FOV: 45 degrees; CFP; 2352 x 1568 pixels:
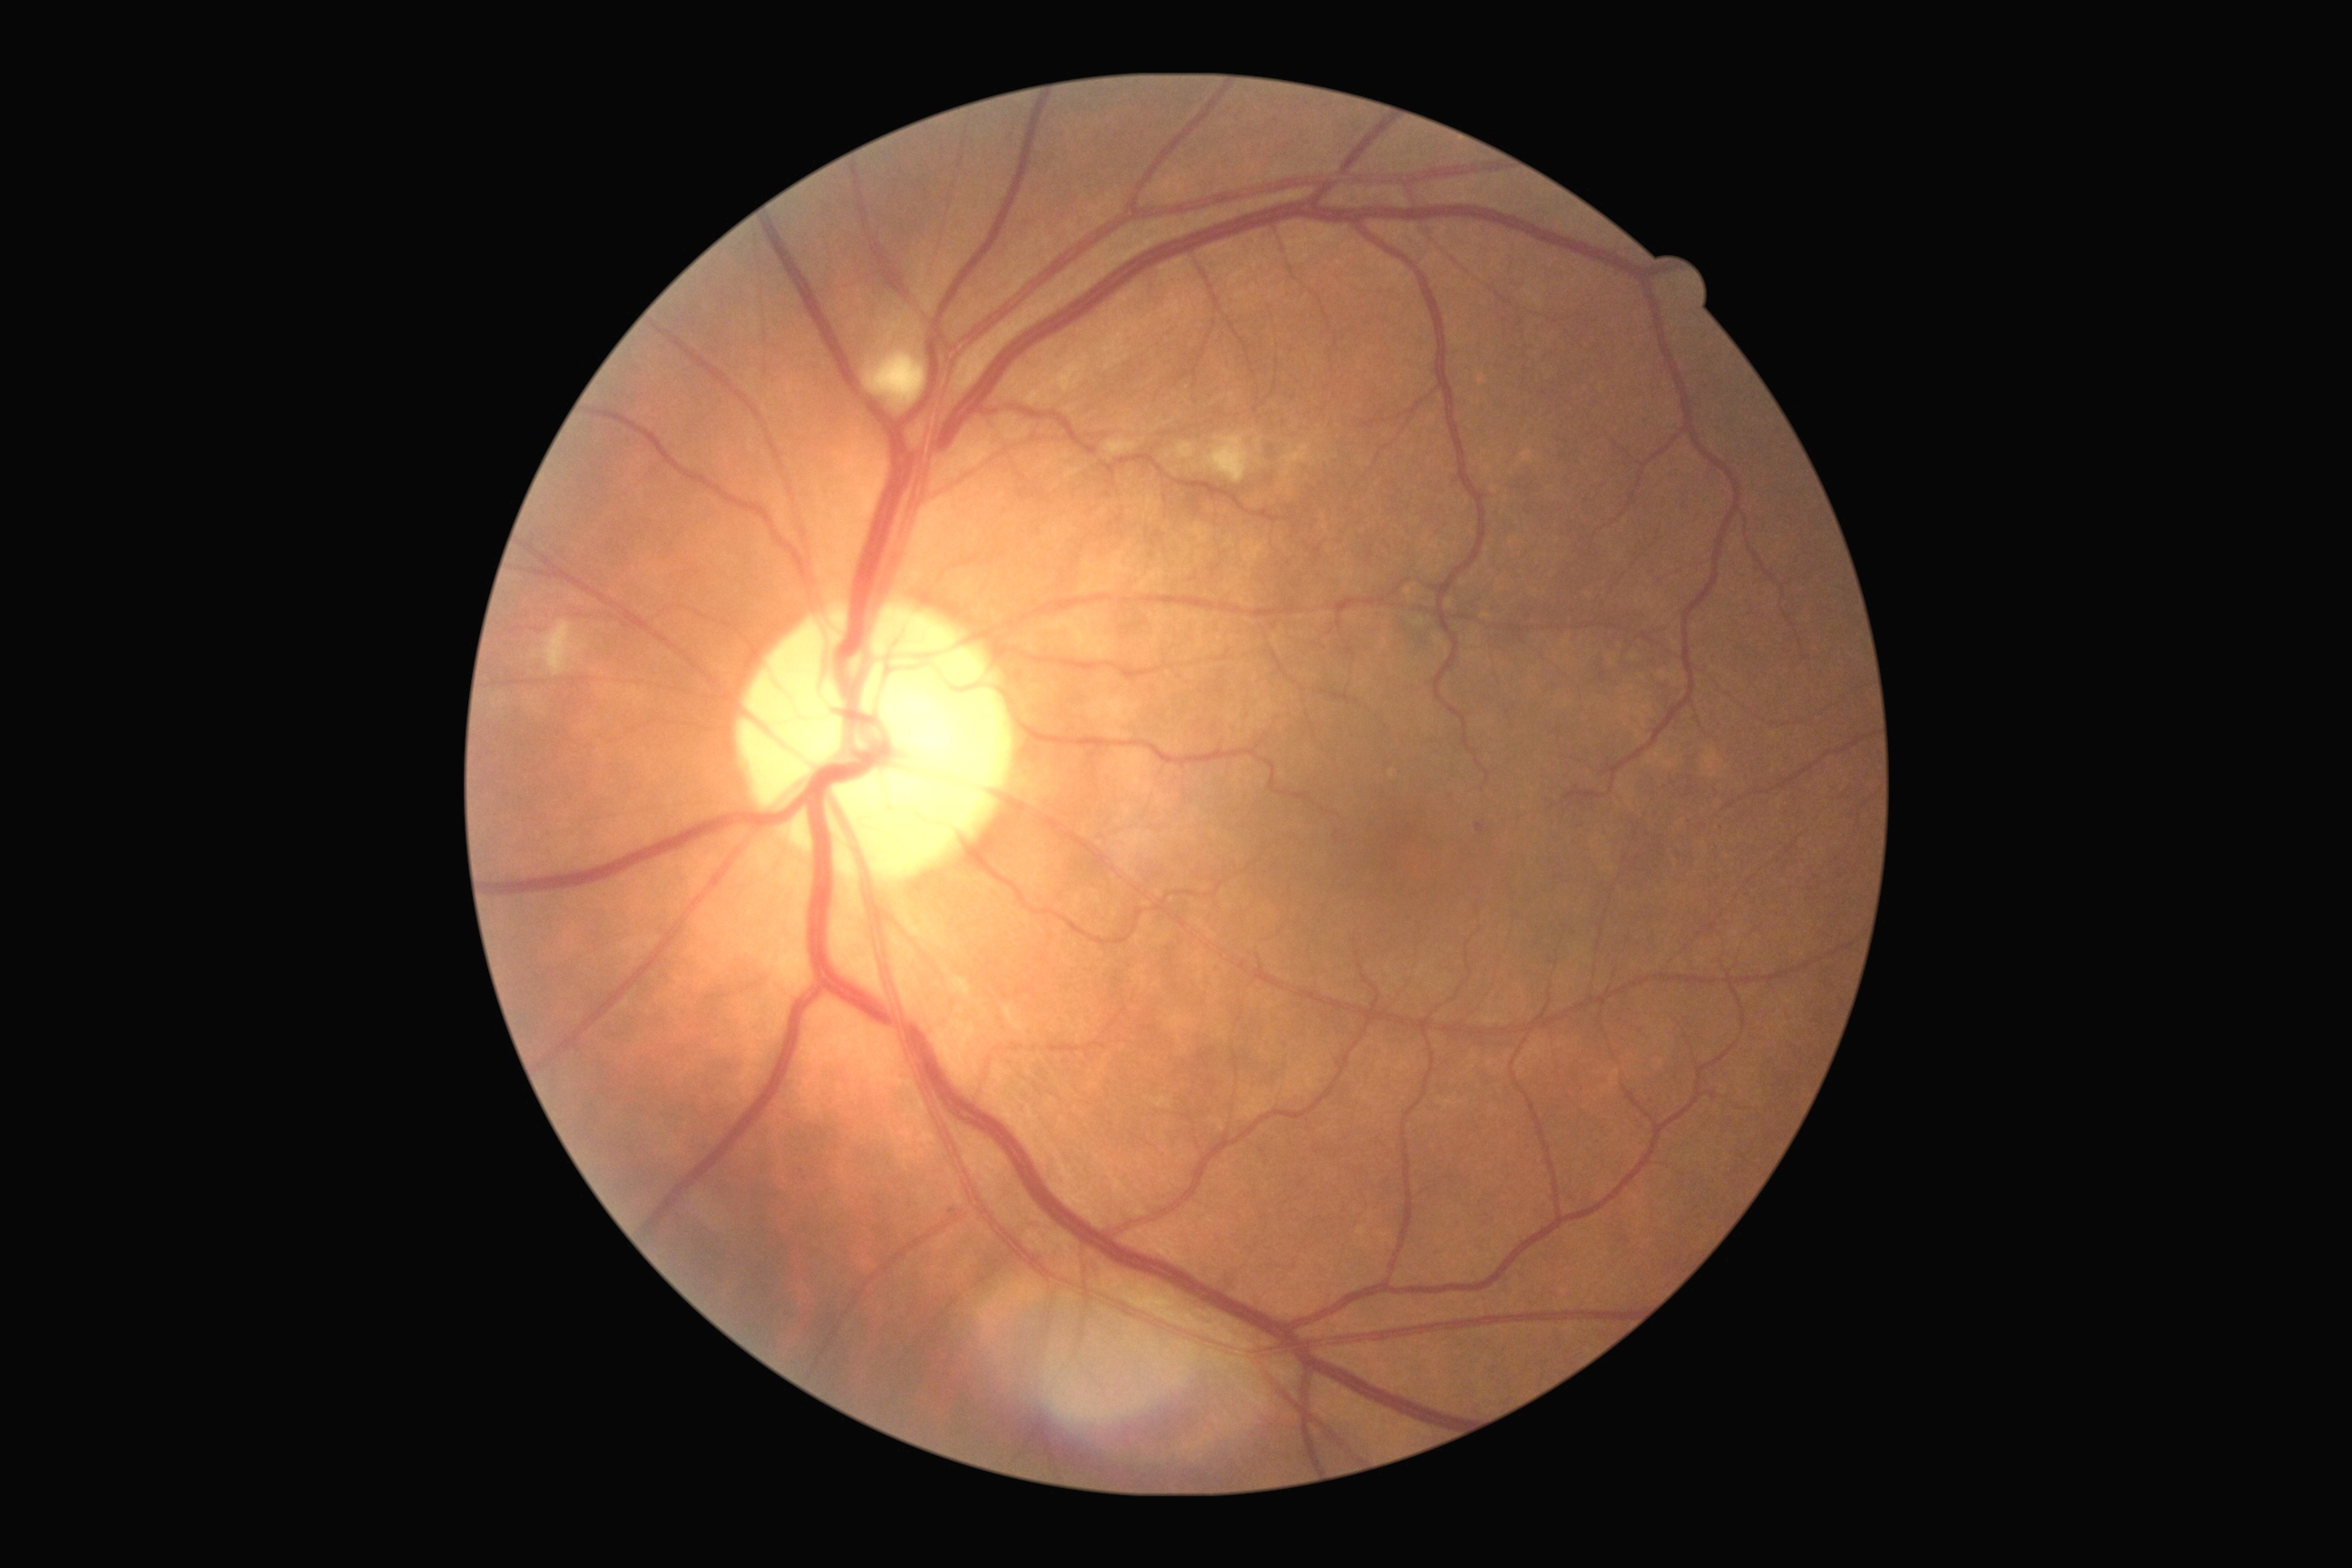 dr_category: non-proliferative diabetic retinopathy
dr_grade: grade 2 (moderate NPDR)